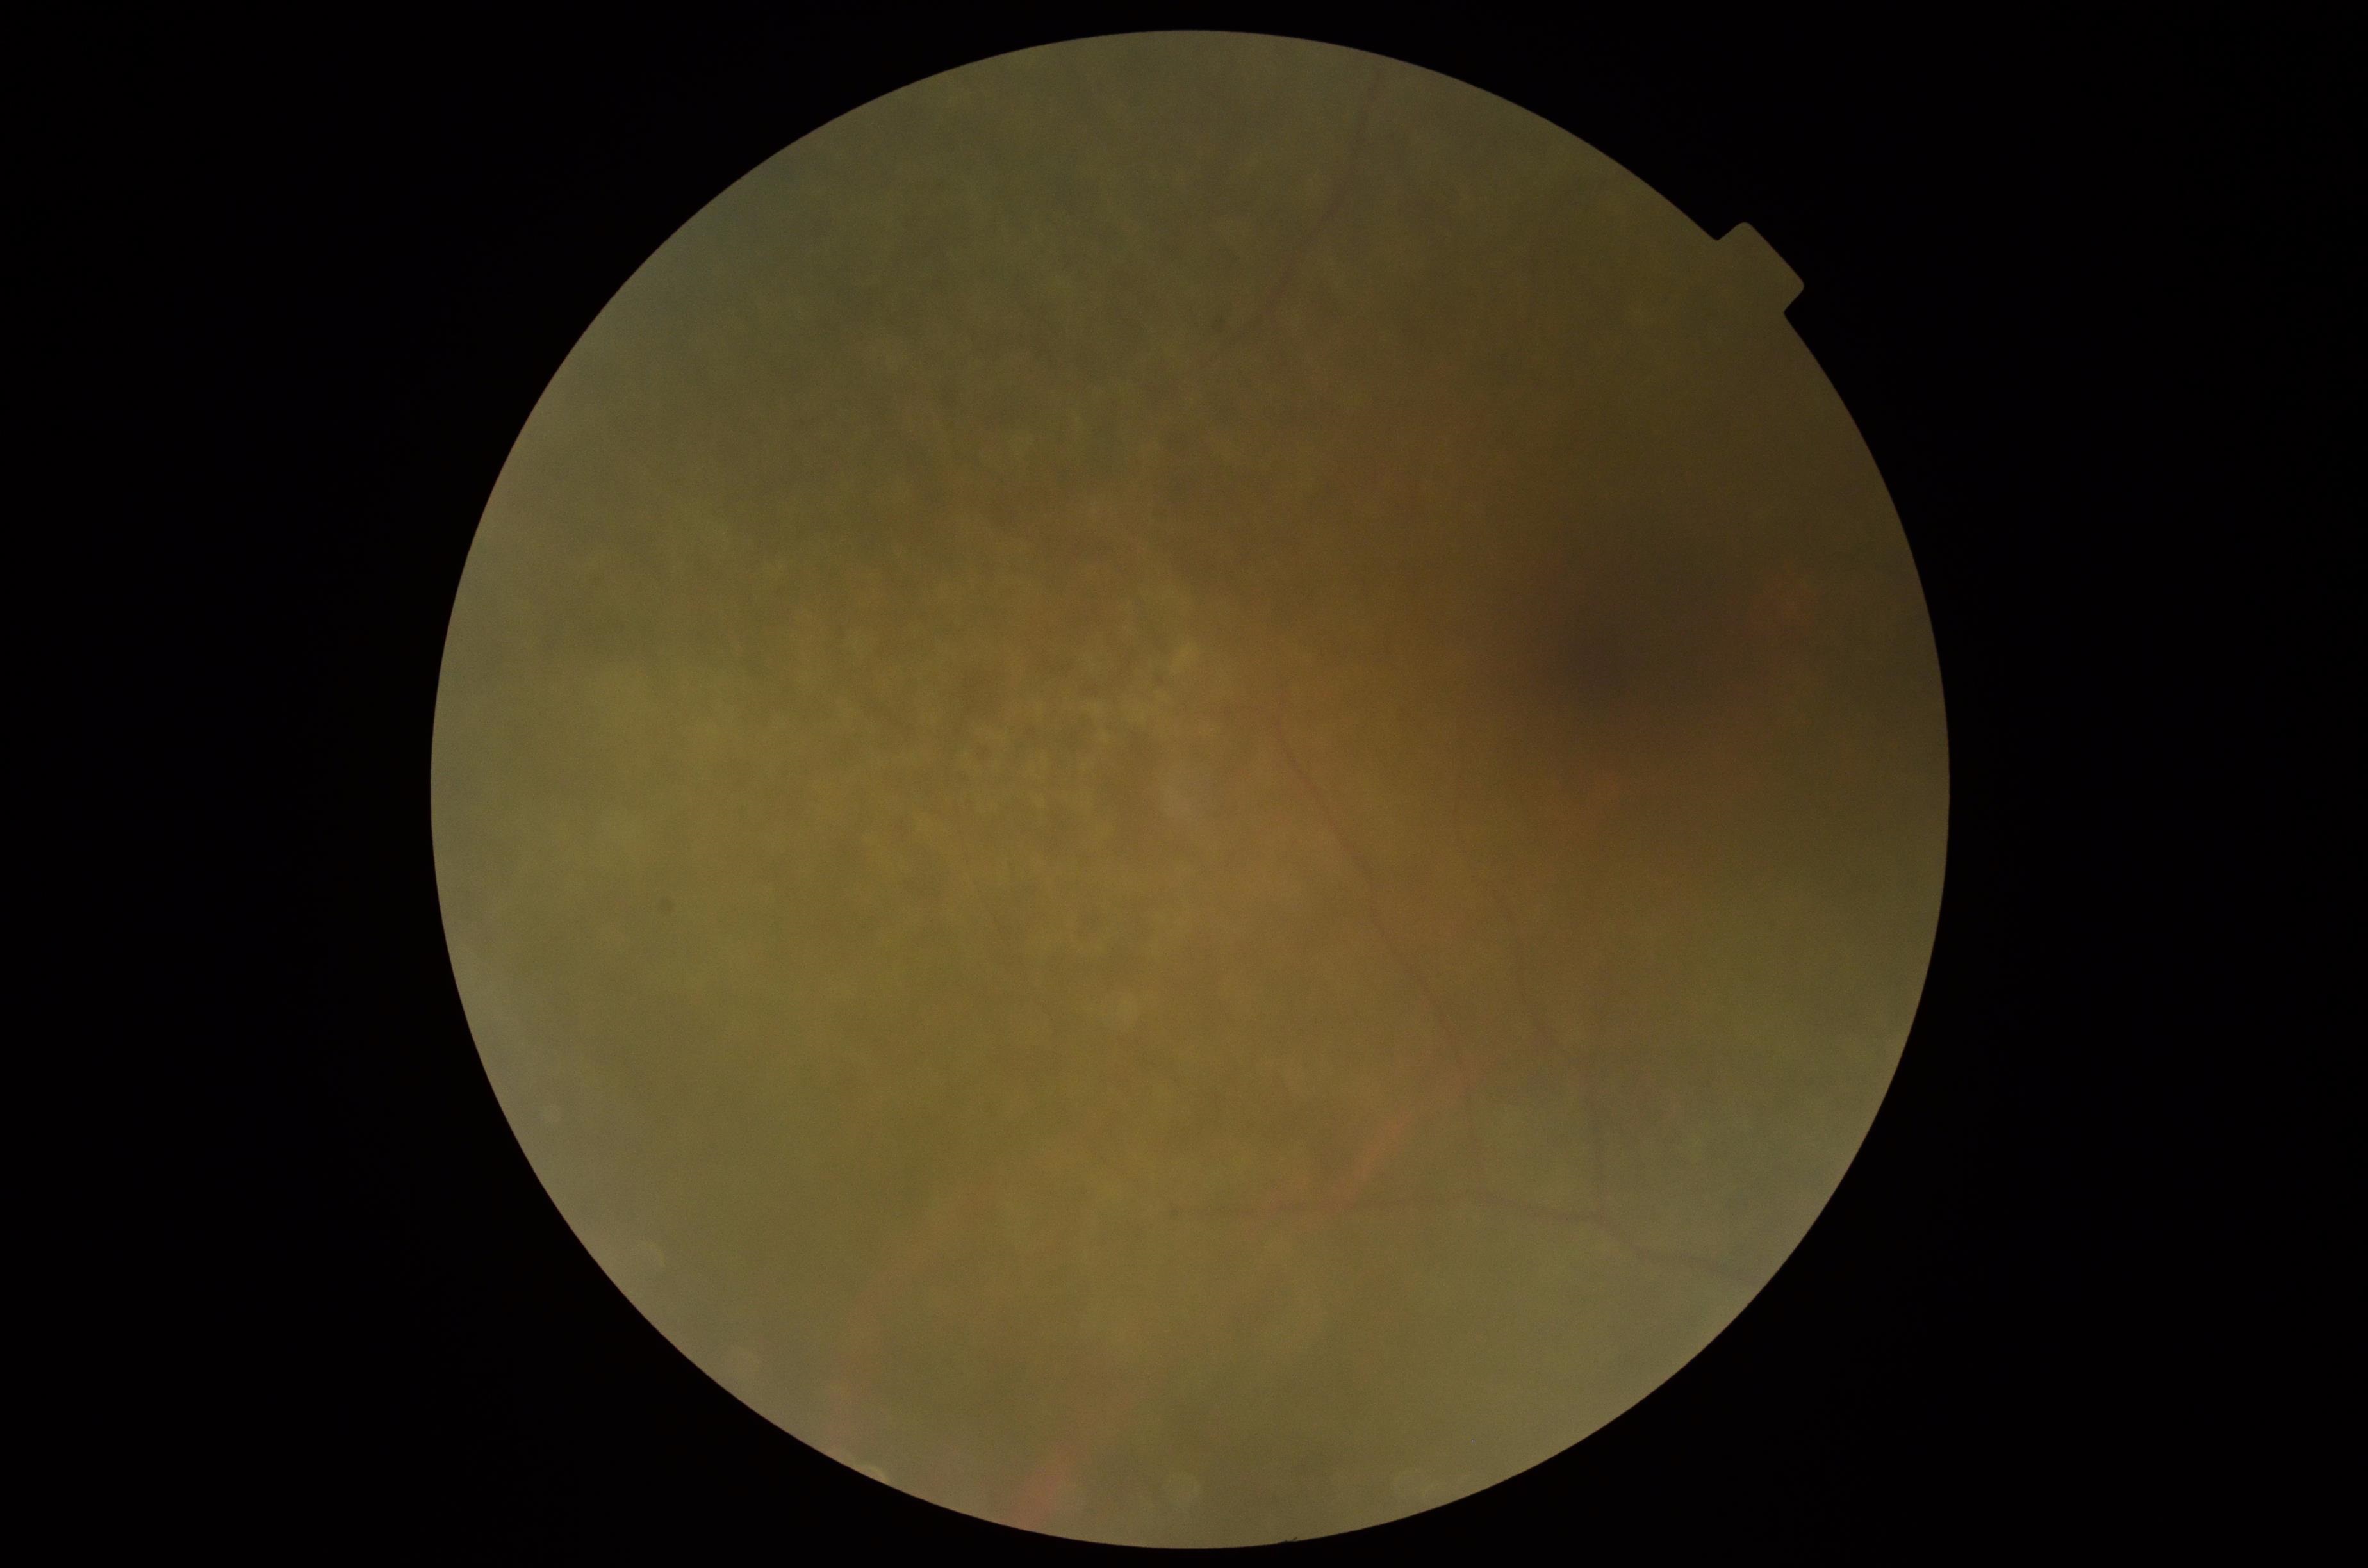 Ungradable image — DR severity cannot be determined. Retinopathy grade: ungradable.